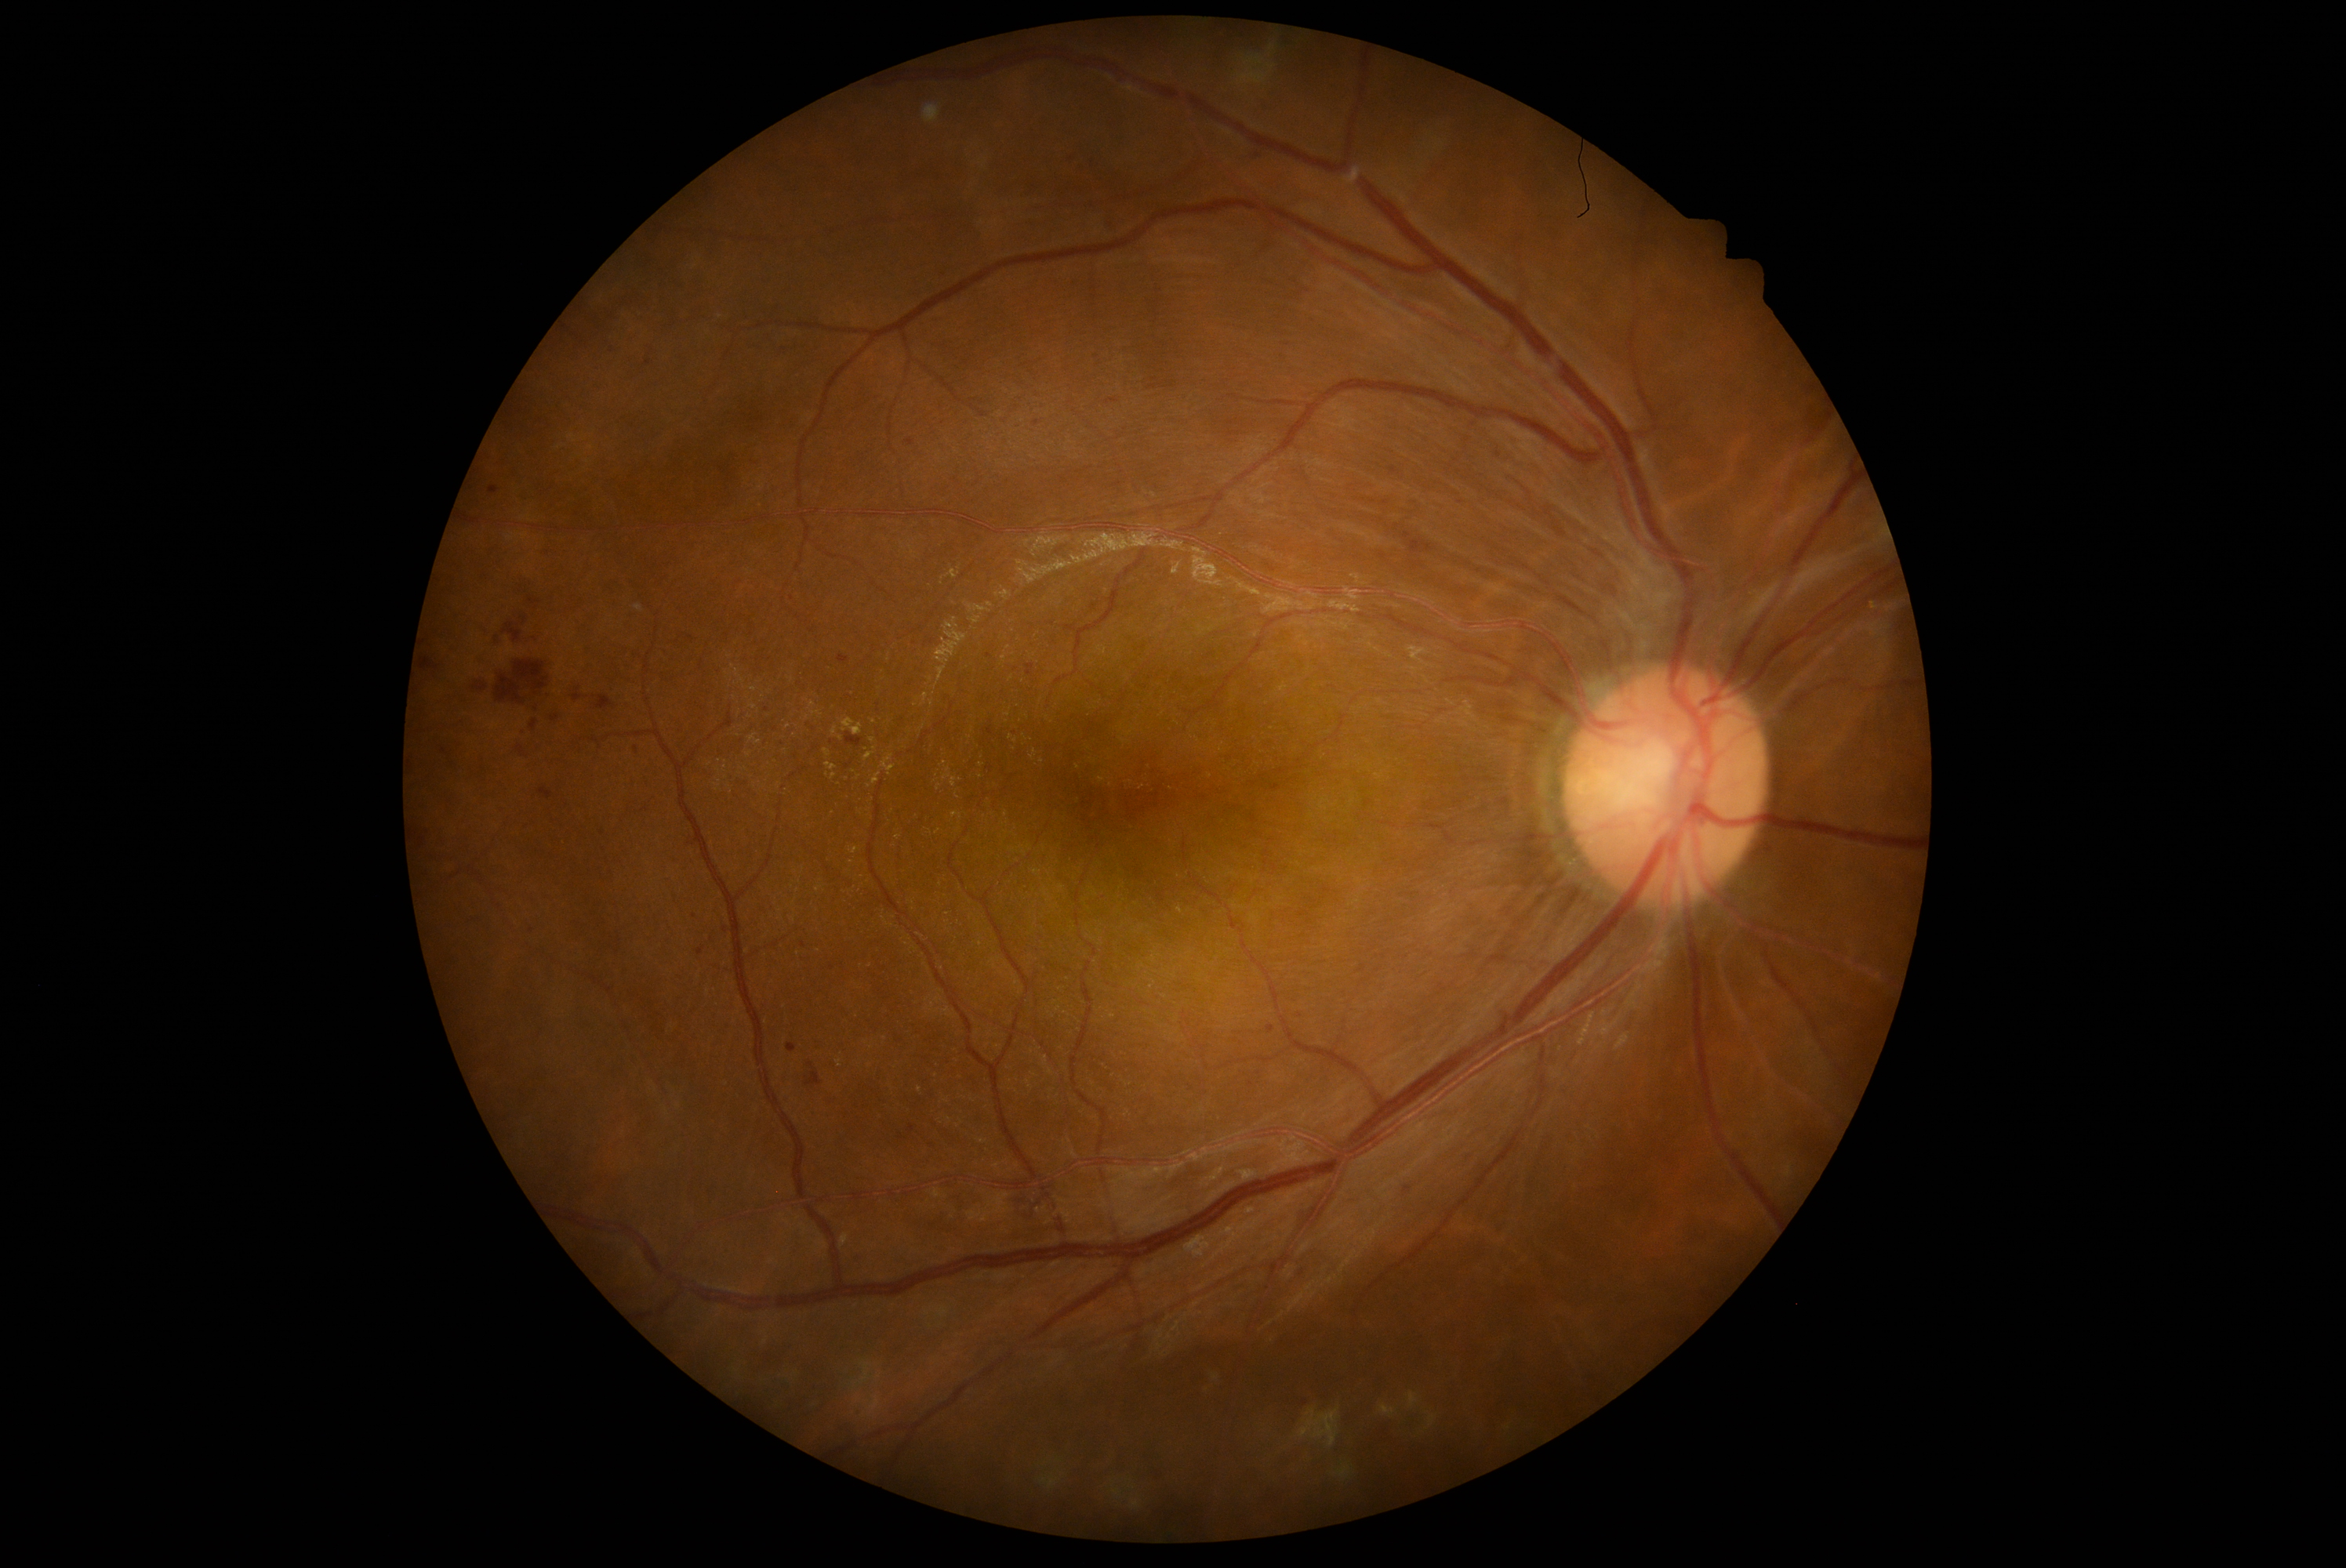 Diabetic retinopathy (DR) is grade 2 (moderate NPDR); non-proliferative diabetic retinopathy
Selected lesions:
hemorrhages (HEs) (continued): <region>418, 837, 426, 849</region> | <region>517, 746, 529, 760</region> | <region>529, 720, 539, 731</region> | <region>473, 683, 487, 692</region> | <region>551, 716, 559, 722</region> | <region>805, 1062, 823, 1086</region> | <region>906, 440, 915, 446</region> | <region>488, 631, 501, 648</region> | <region>1268, 1025, 1276, 1034</region> | <region>838, 656, 849, 664</region> | <region>986, 728, 993, 736</region> | <region>594, 697, 616, 710</region> | <region>520, 617, 528, 626</region>
Additional small HEs near {"x": 1036, "y": 424} | {"x": 1300, "y": 1017} | {"x": 636, "y": 750}
hard exudates (EXs) (continued): <region>881, 755, 896, 772</region> | <region>953, 813, 962, 819</region> | <region>865, 753, 874, 761</region> | <region>871, 772, 882, 785</region>
Additional small EXs near {"x": 835, "y": 731} | {"x": 899, "y": 838} | {"x": 938, "y": 831} | {"x": 938, "y": 787} | {"x": 841, "y": 738} | {"x": 873, "y": 740} | {"x": 866, "y": 750} | {"x": 873, "y": 722}